50° FOV — 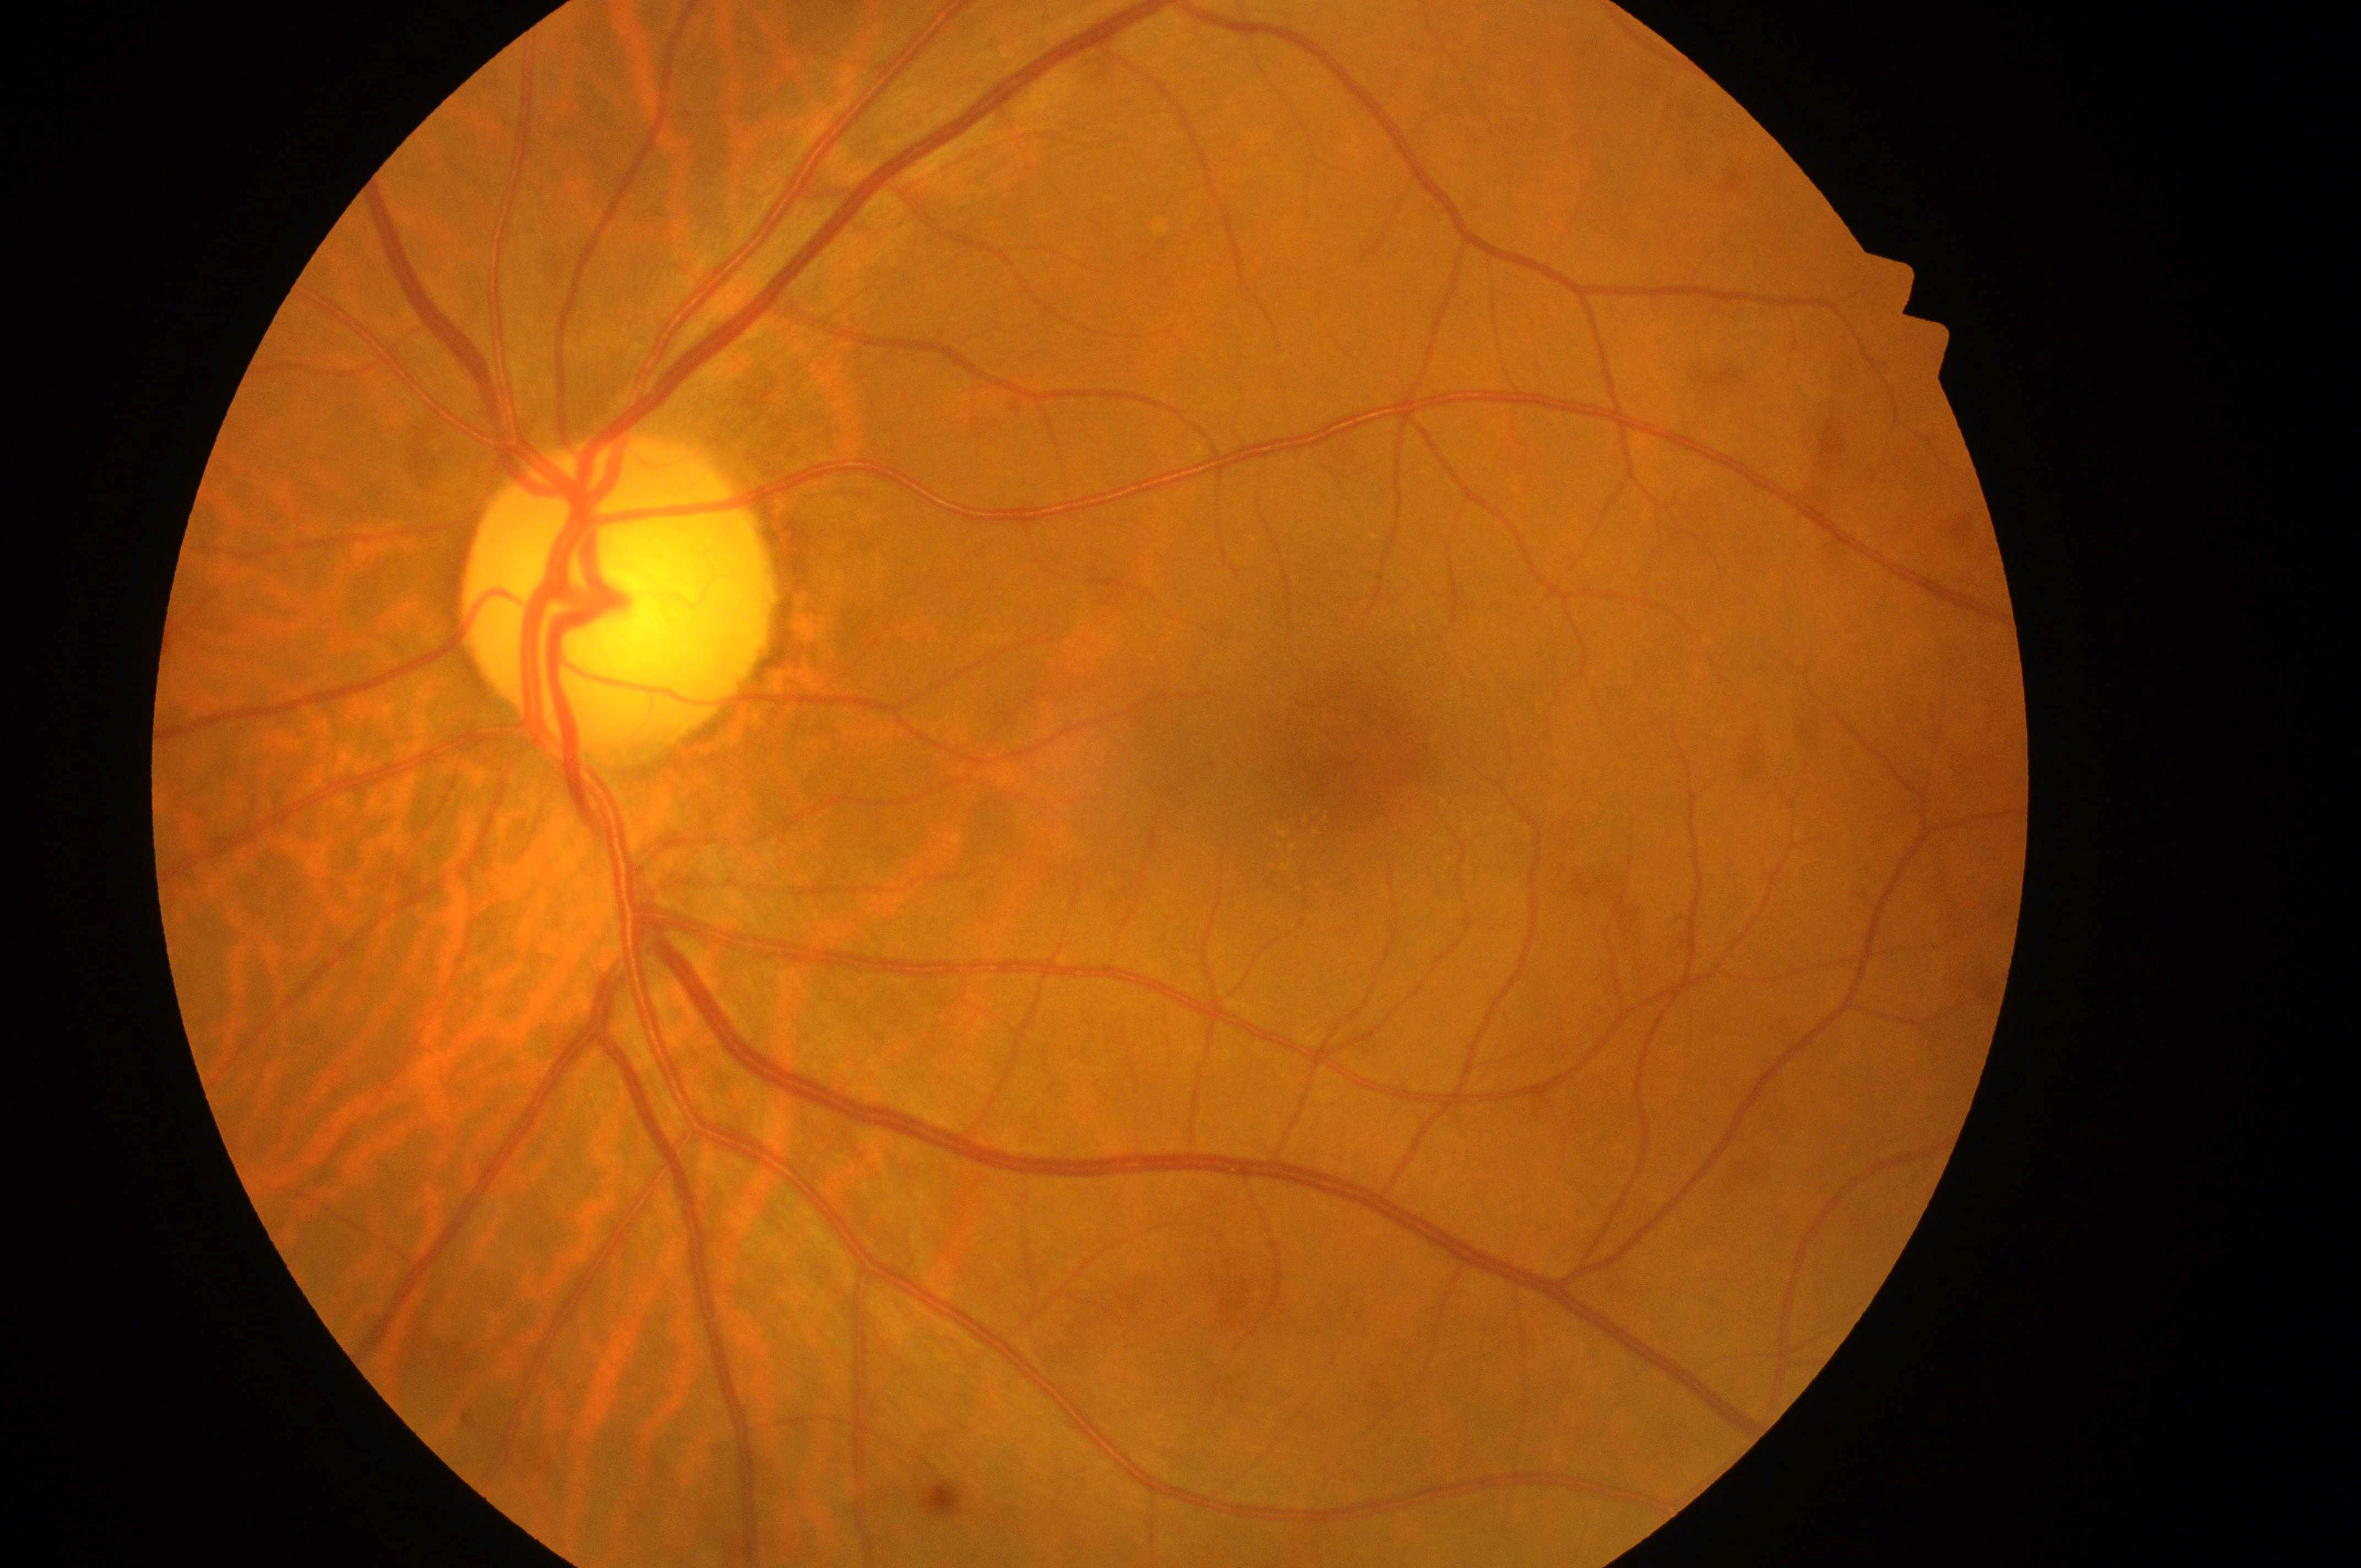 optic disk=(612,606); left eye; diabetic retinopathy (DR)=grade 0 (no apparent retinopathy); foveal center=(1355,759); diabetic macular edema (DME)=grade 0 (no risk).